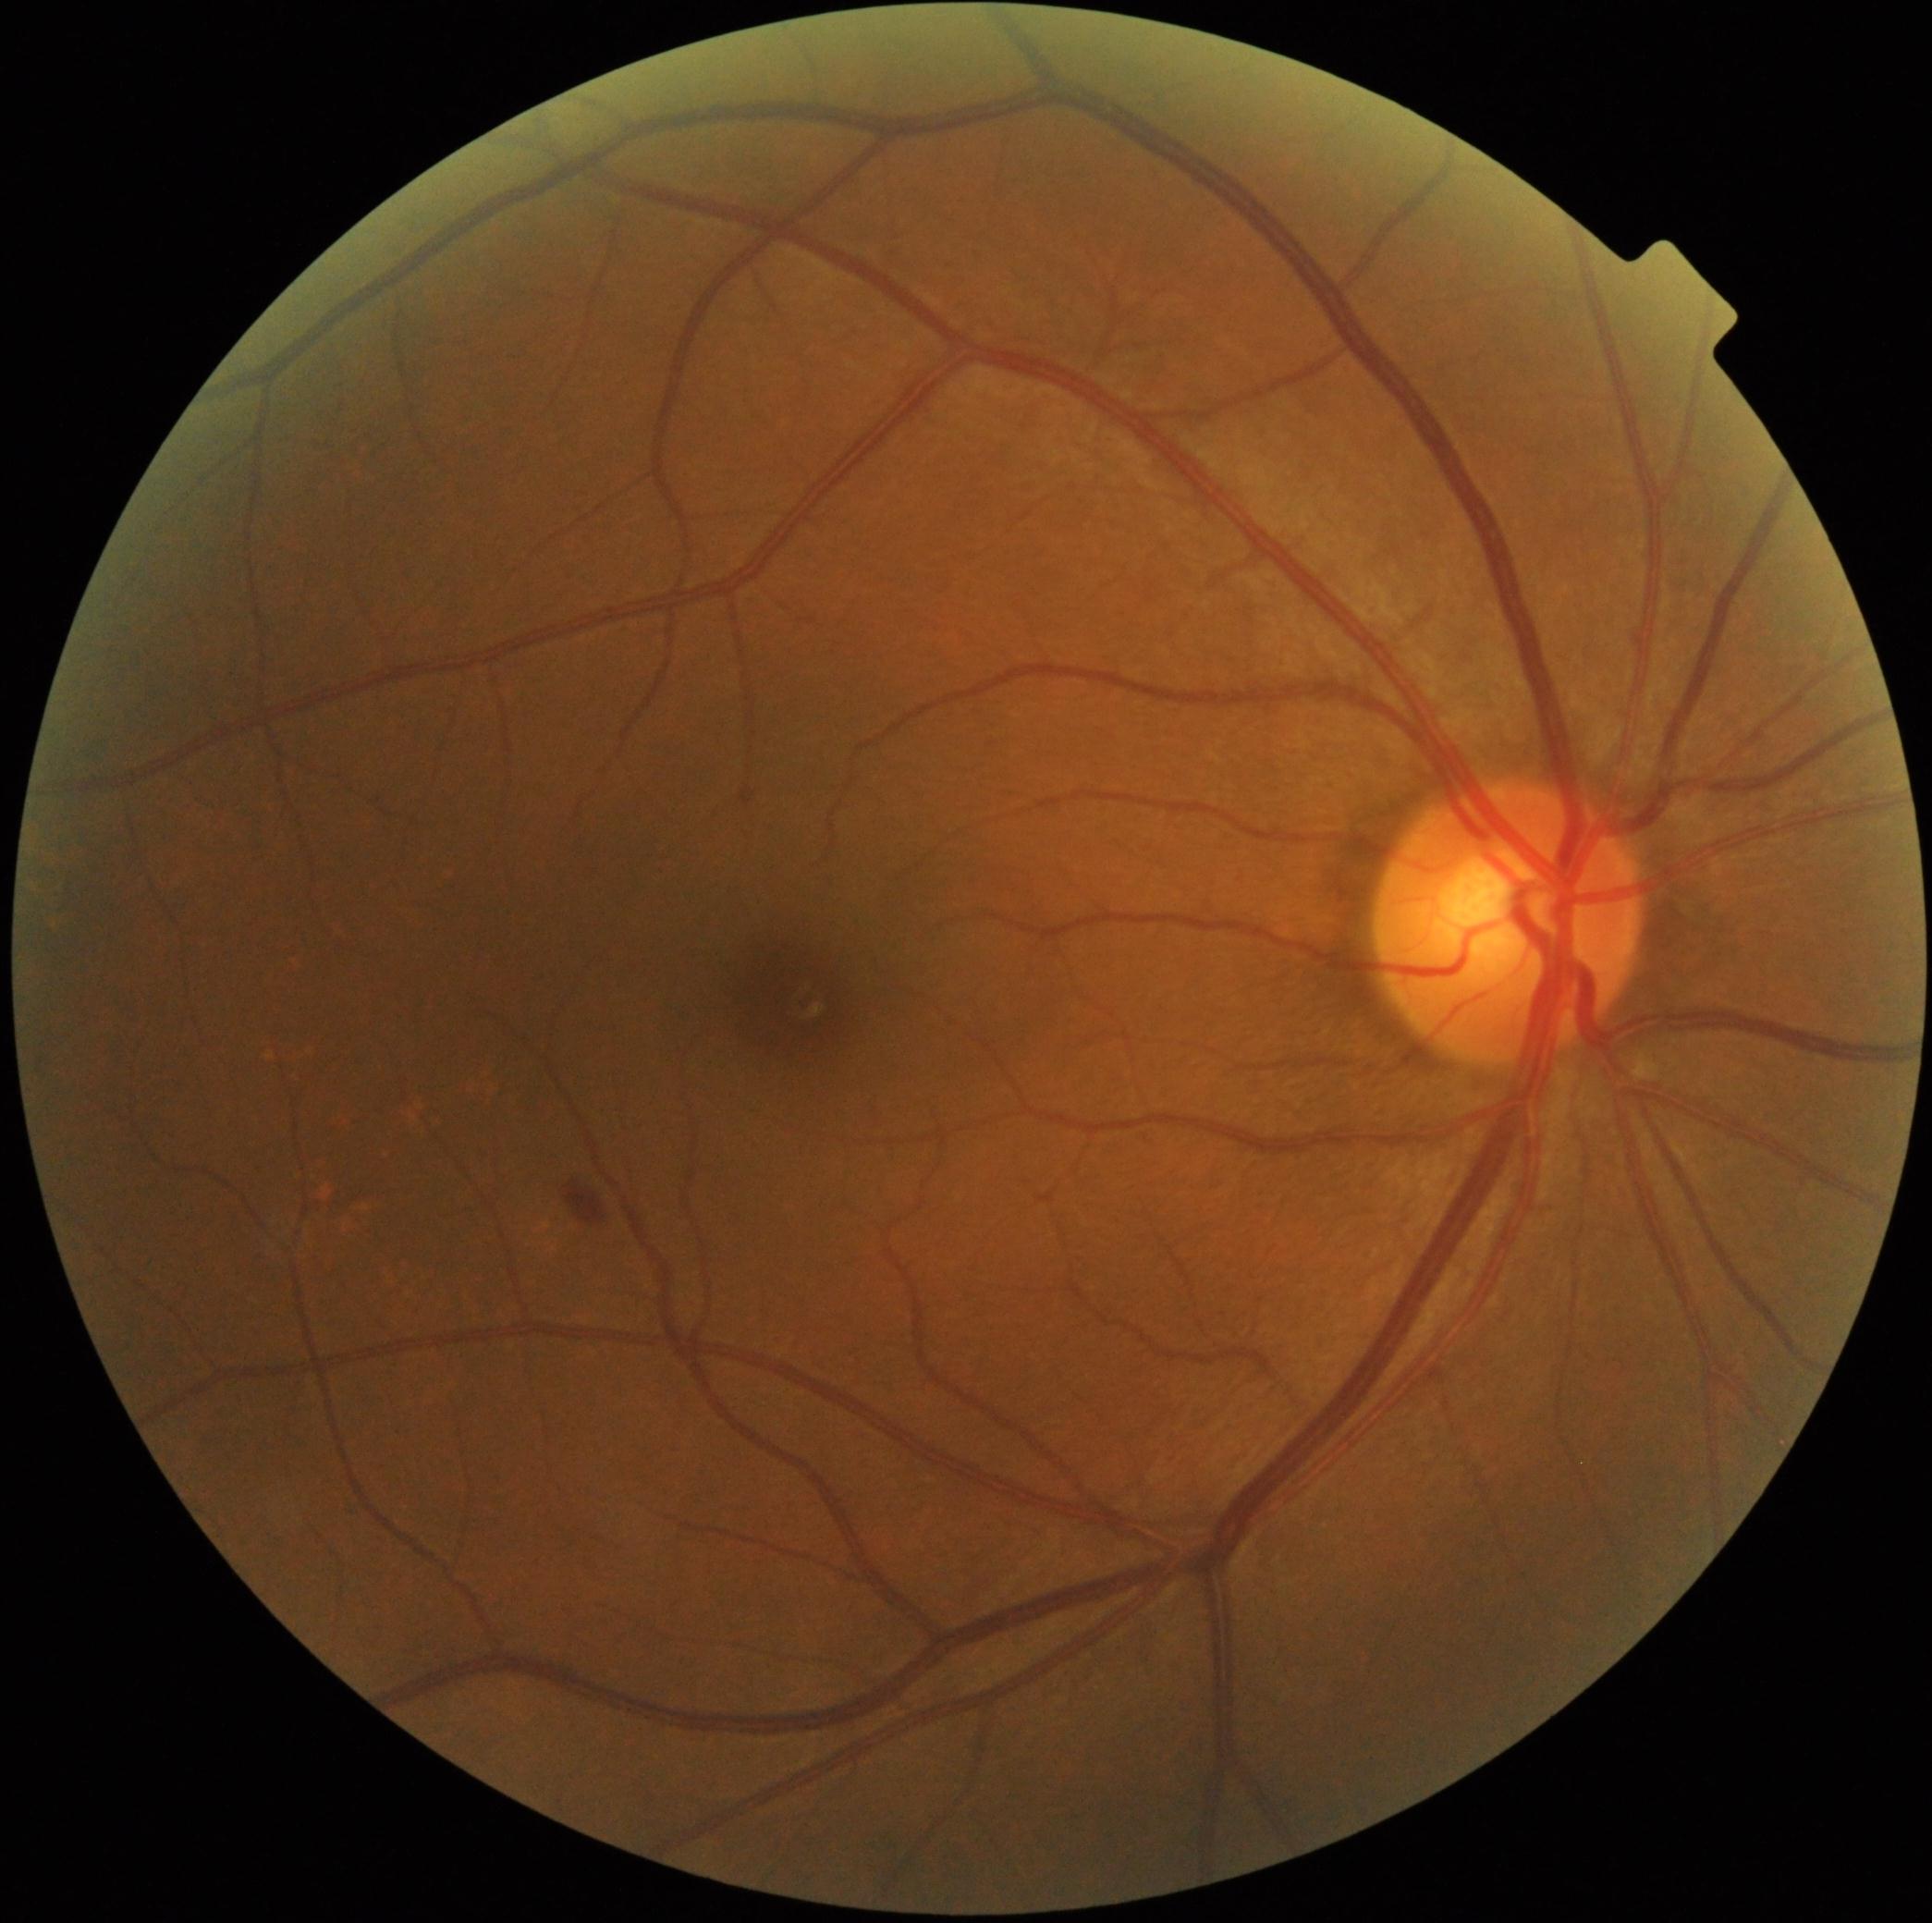
{"dr_grade": "grade 2", "dr_category": "non-proliferative diabetic retinopathy"}